CFP
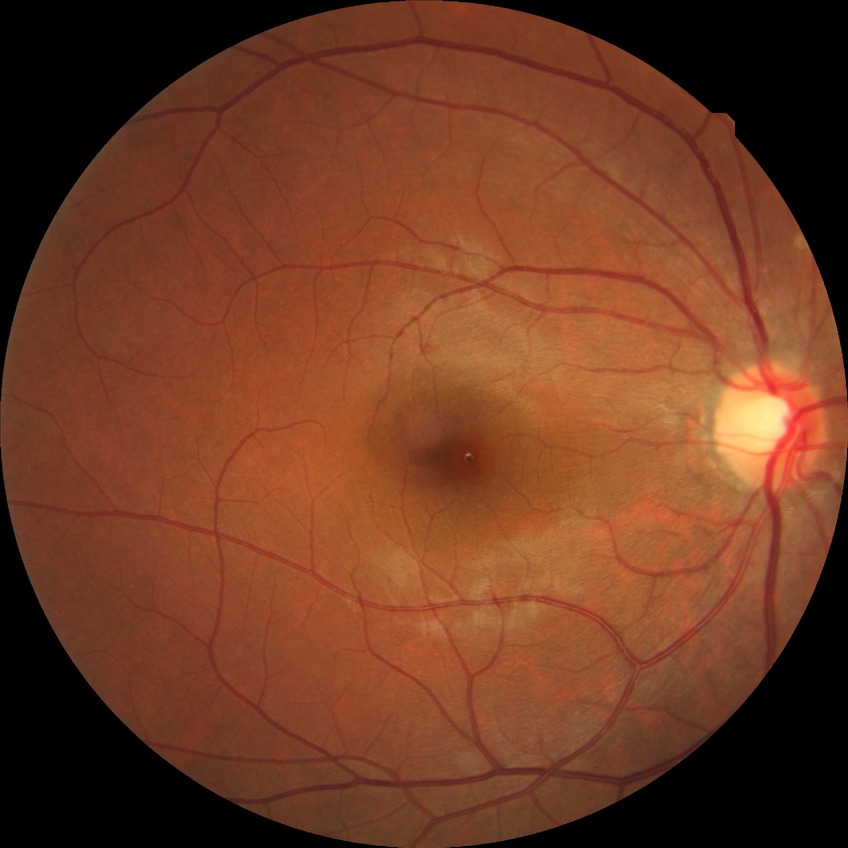

DR impression = no signs of DR; DR grade = NDR.